Wide-field fundus image from infant ROP screening · 640x480px · captured with the Clarity RetCam 3 (130° field of view) — 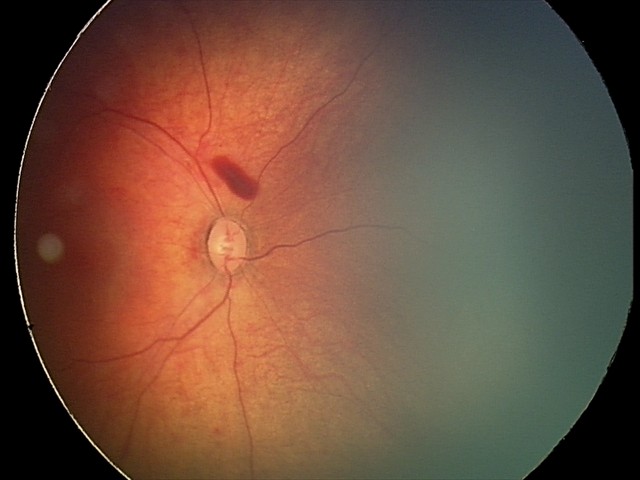 Q: What was the screening finding?
A: retinal hemorrhages